Color fundus image · 50° field of view · captured after pupil dilation · 2228 x 1652 pixels: 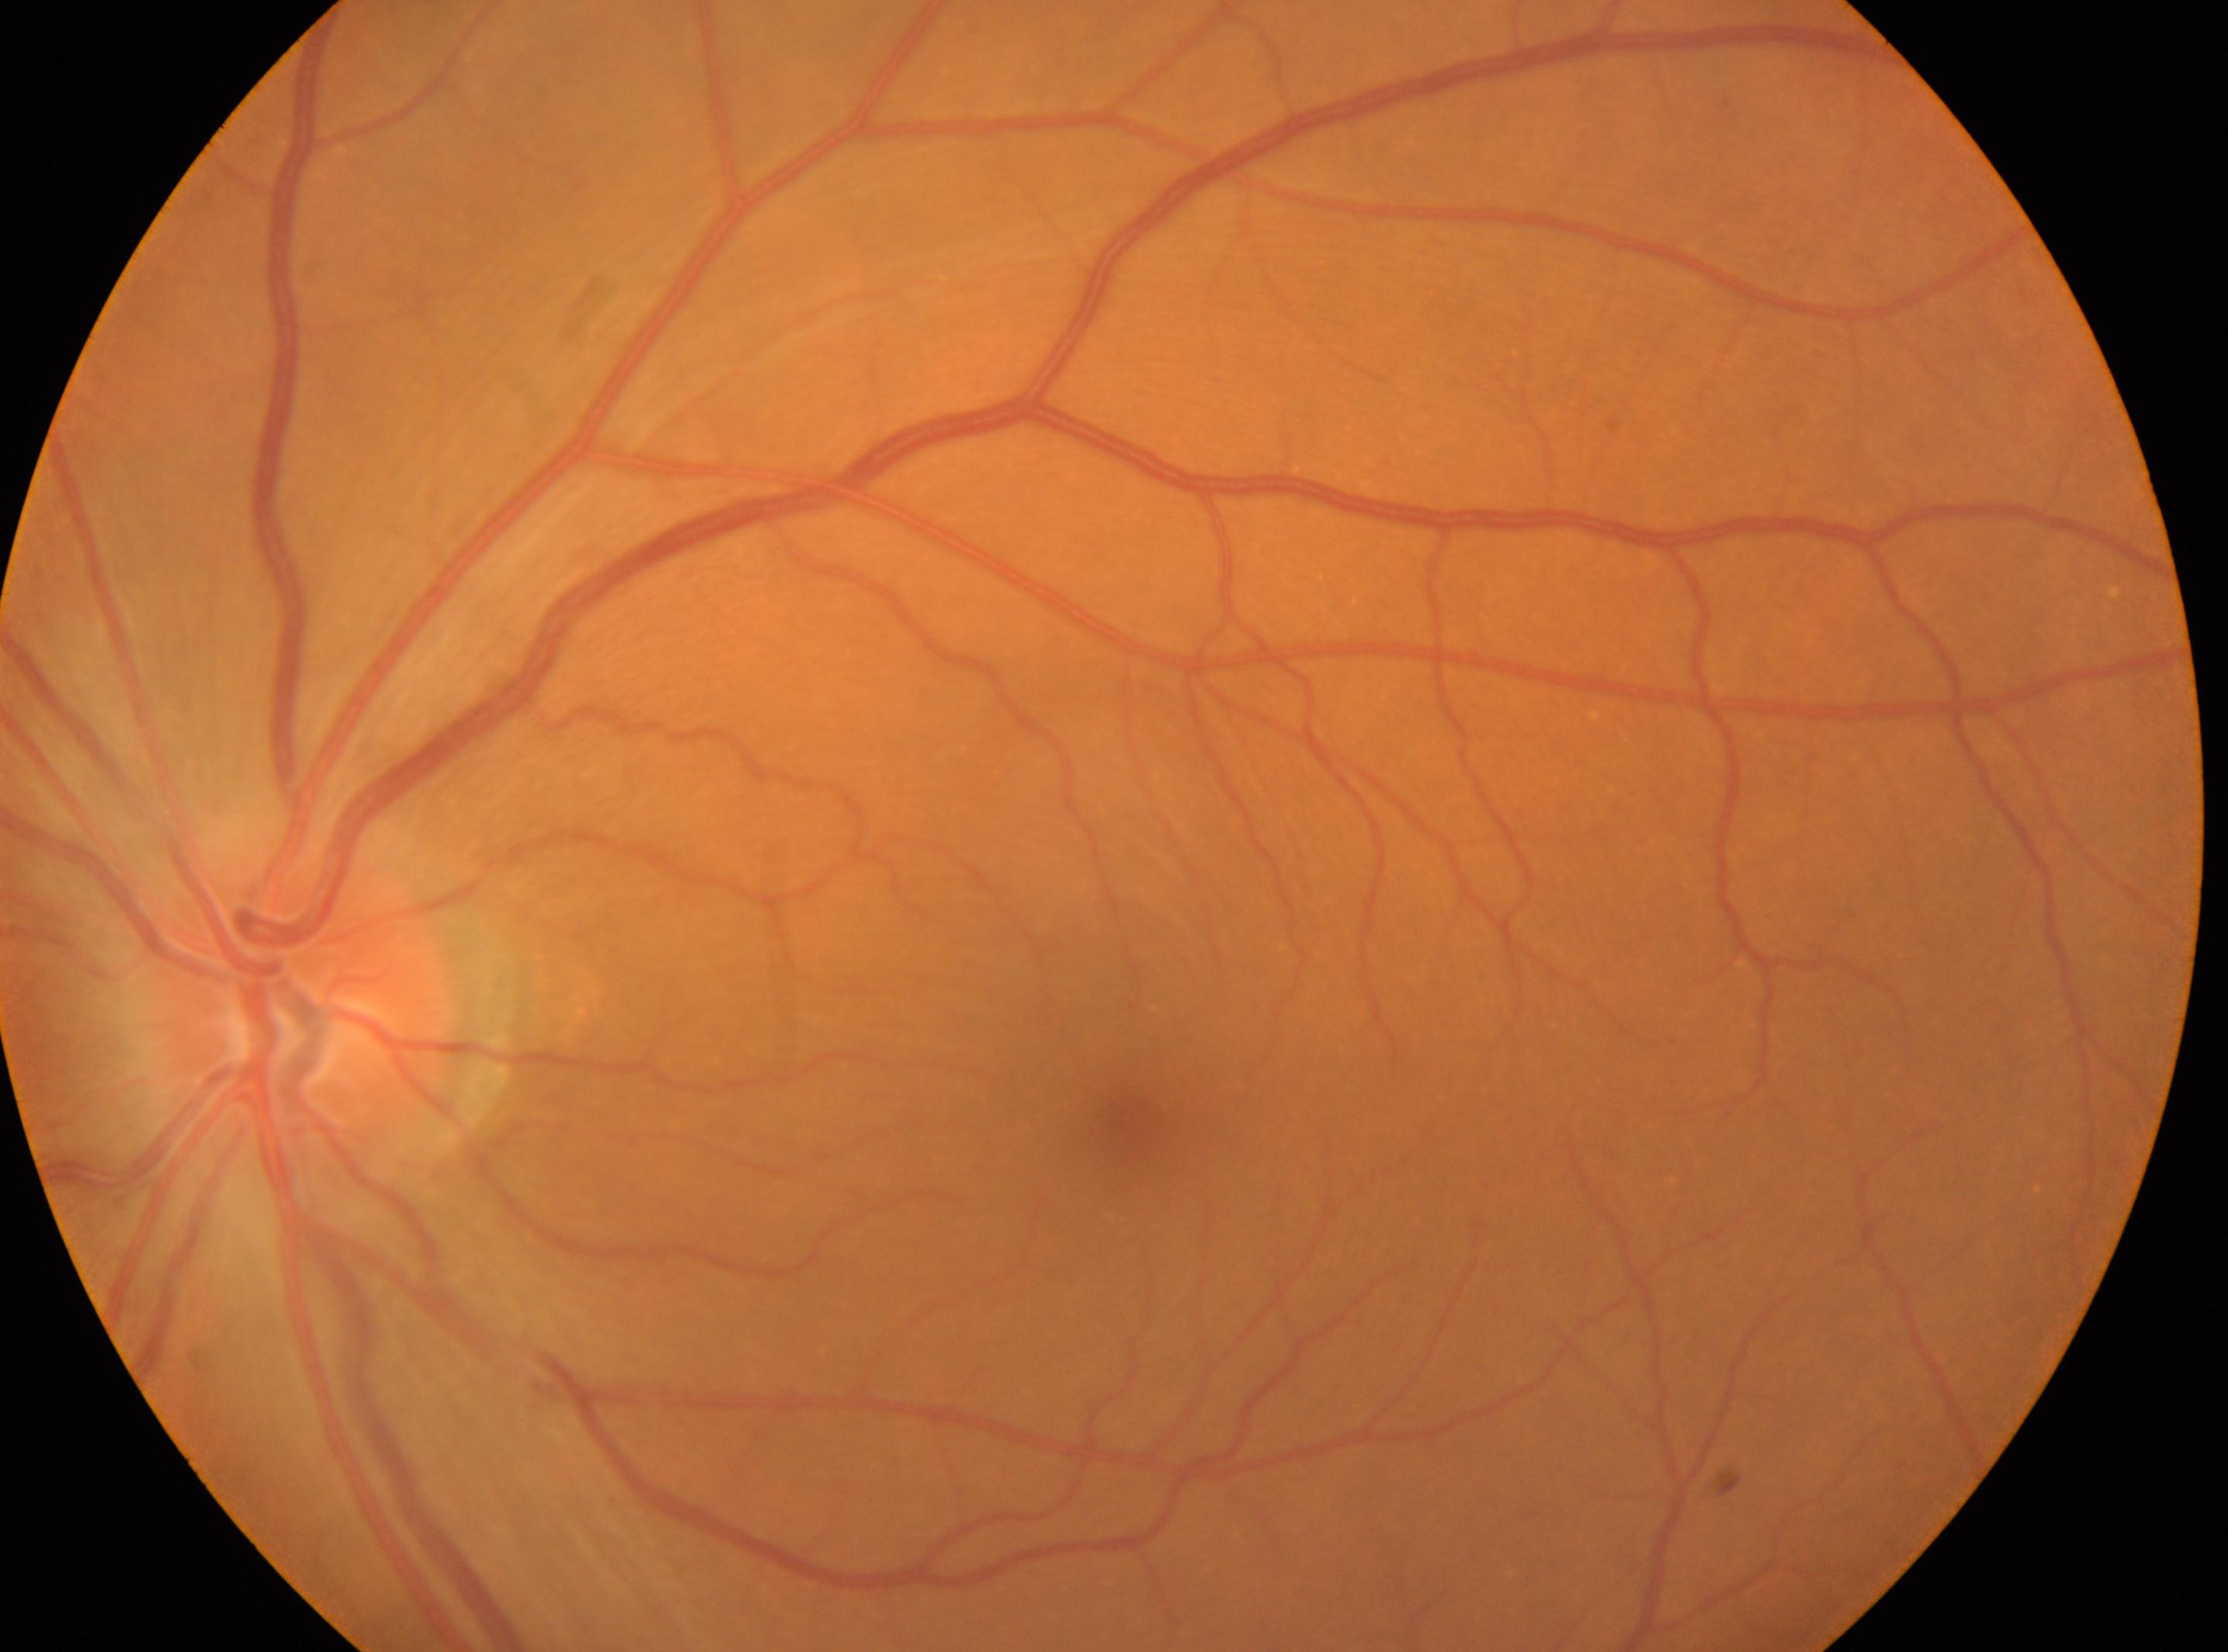
The optic nerve head is at 306px, 1008px.
This is the oculus sinister.
Macular center located at 1128px, 1114px.
Retinopathy grade is 0 (no apparent retinopathy).